Color fundus photograph, 2352x1568px.
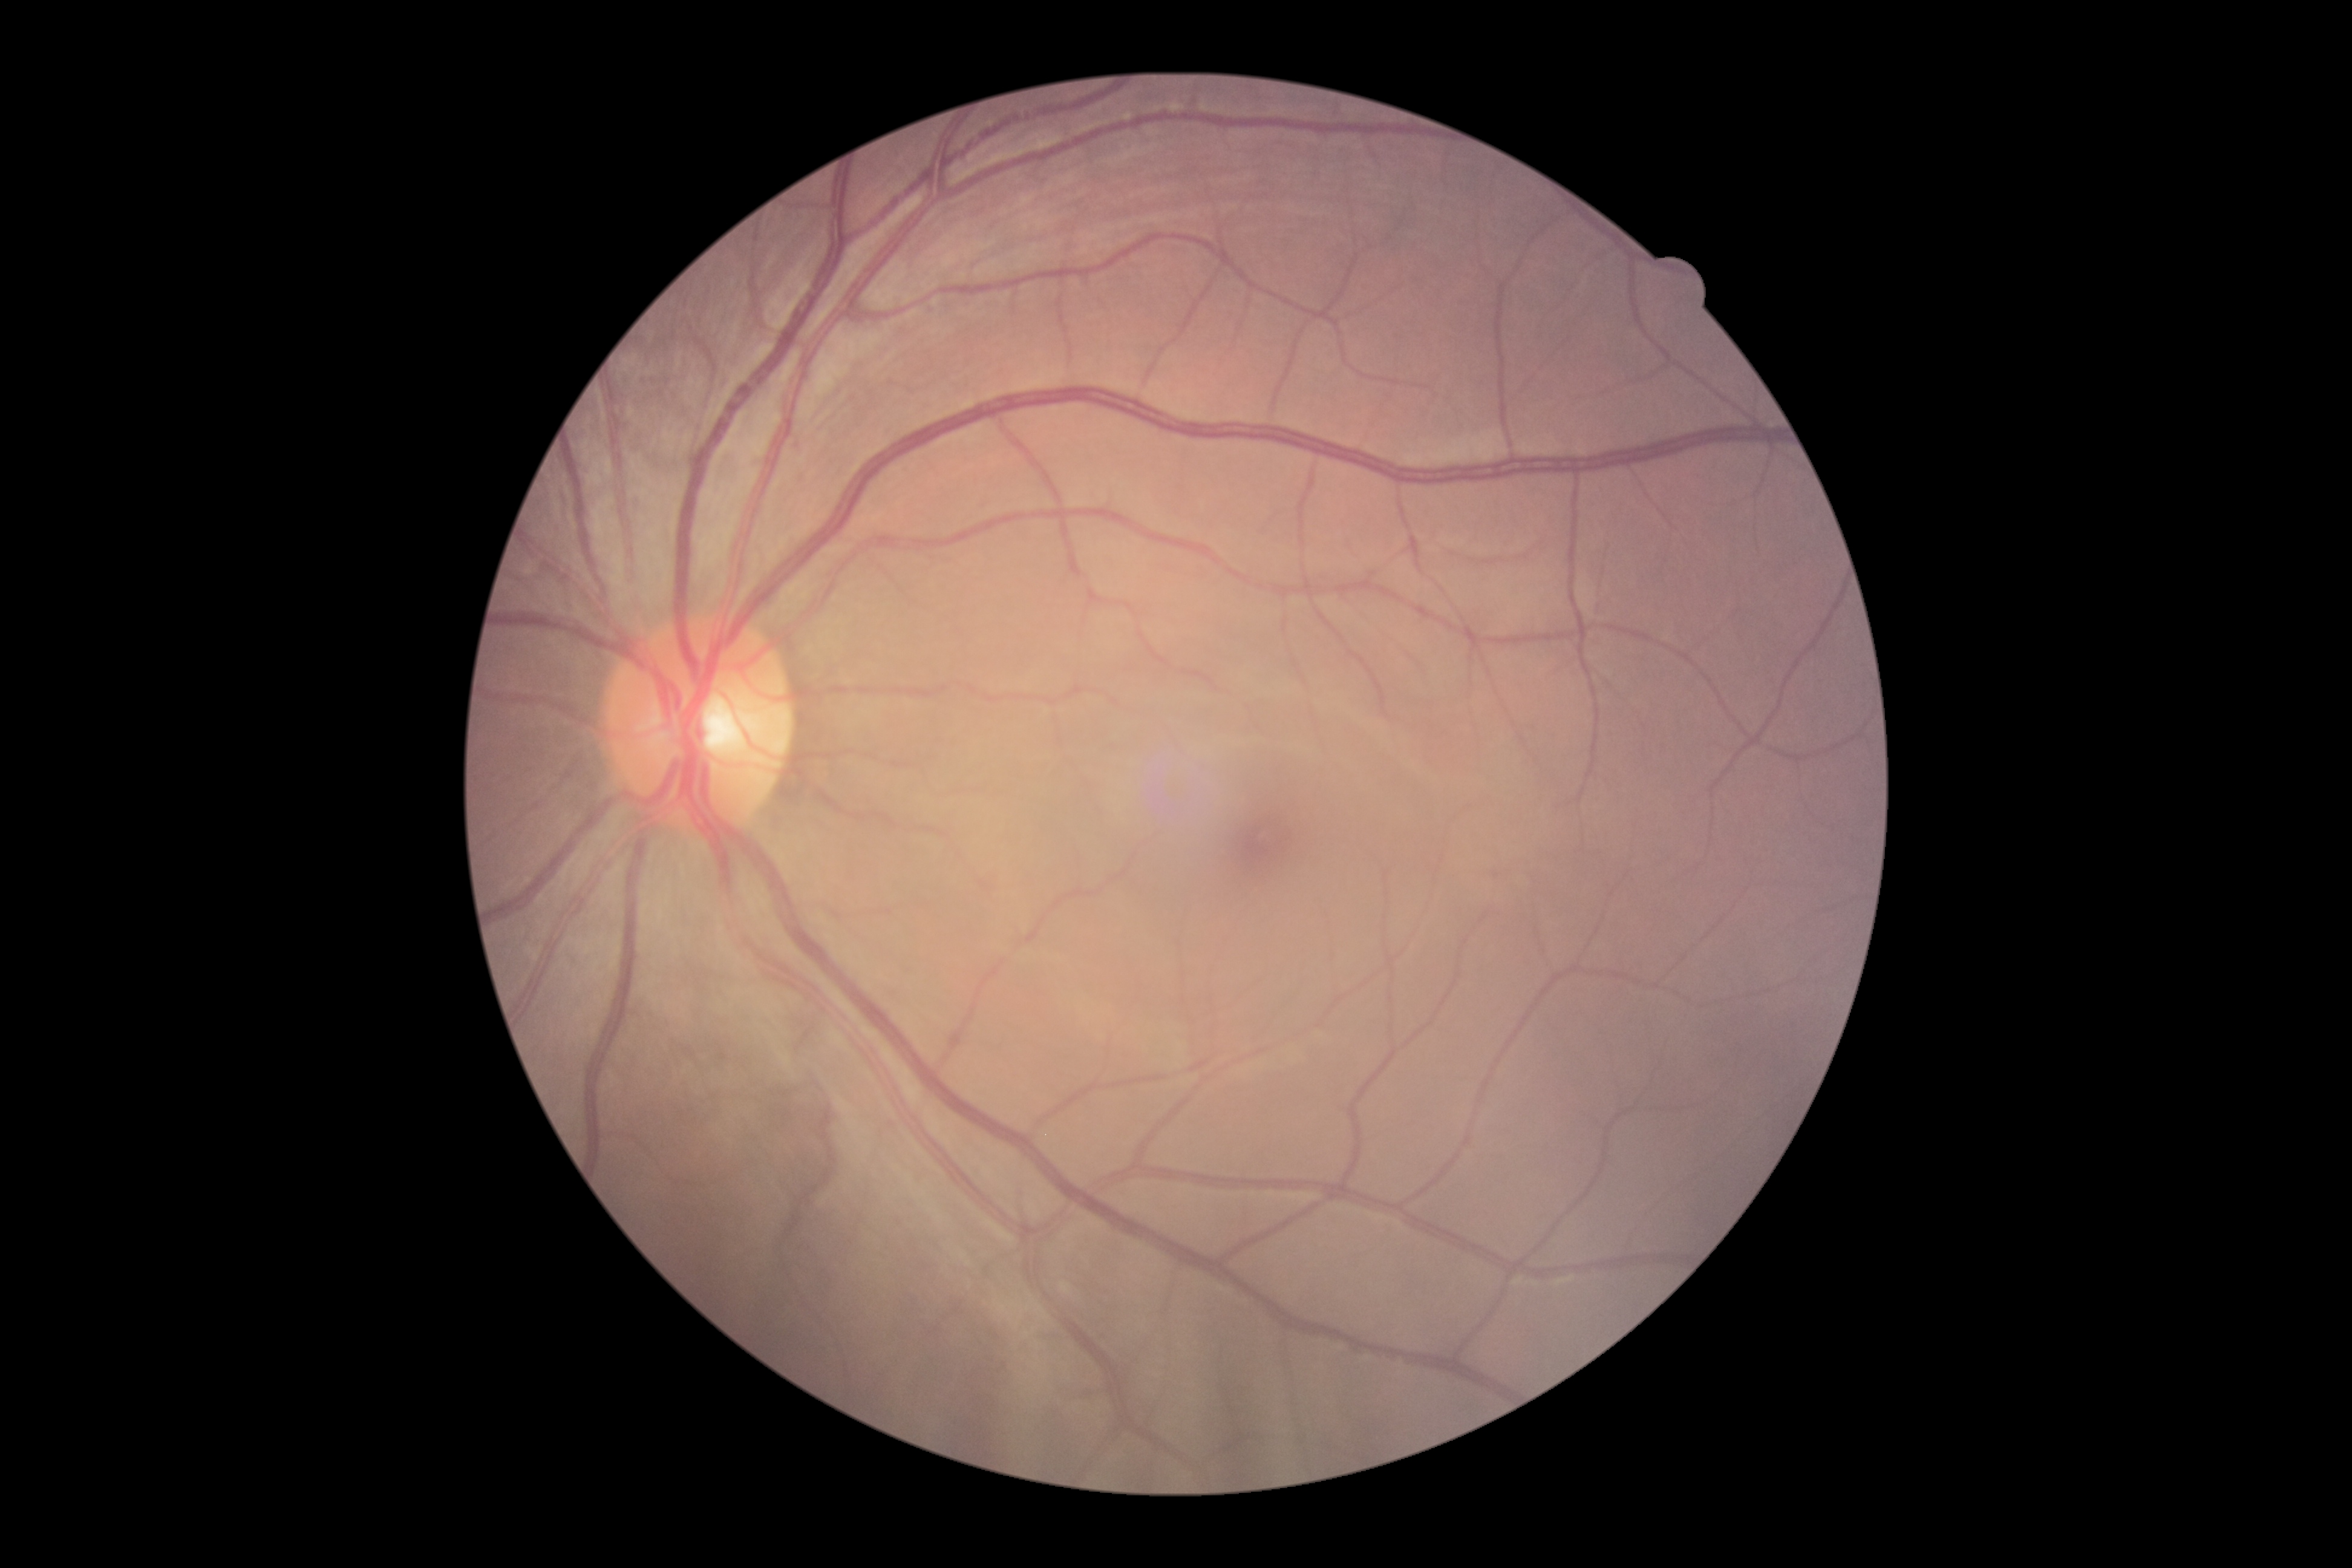

  dr_grade: no apparent retinopathy (grade 0)